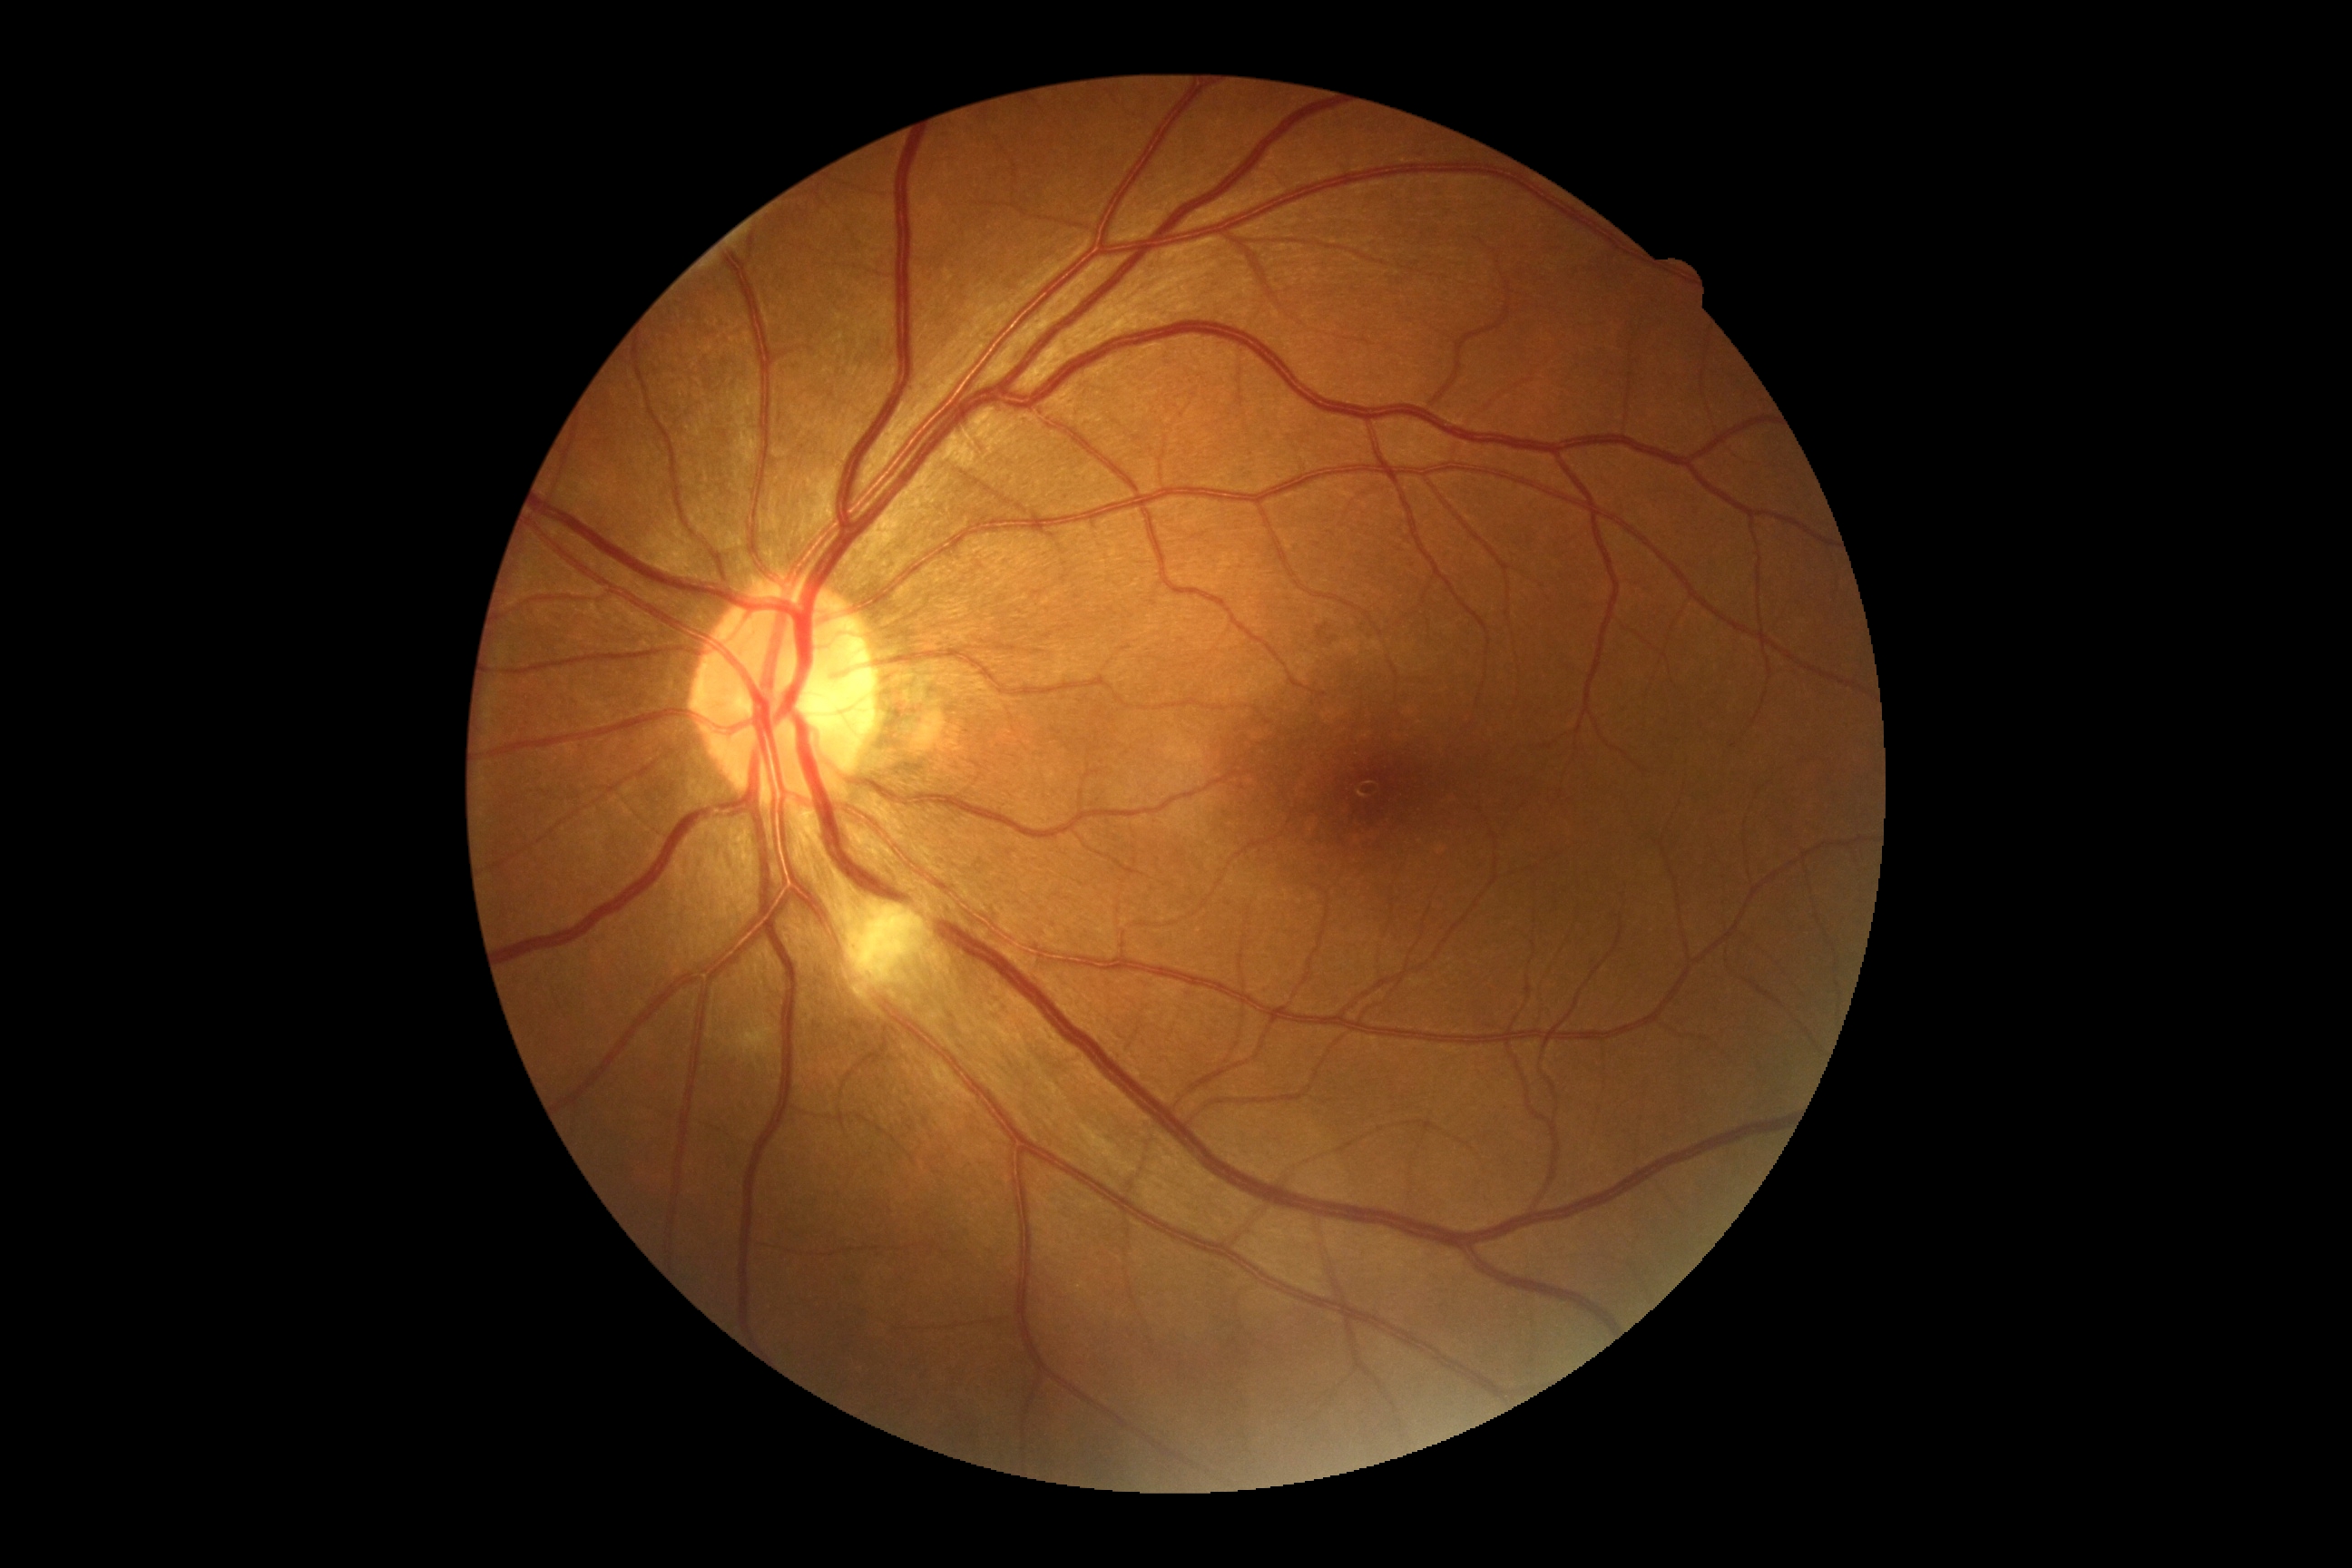
DR grade is 2.